45° FOV. 2352x1568: 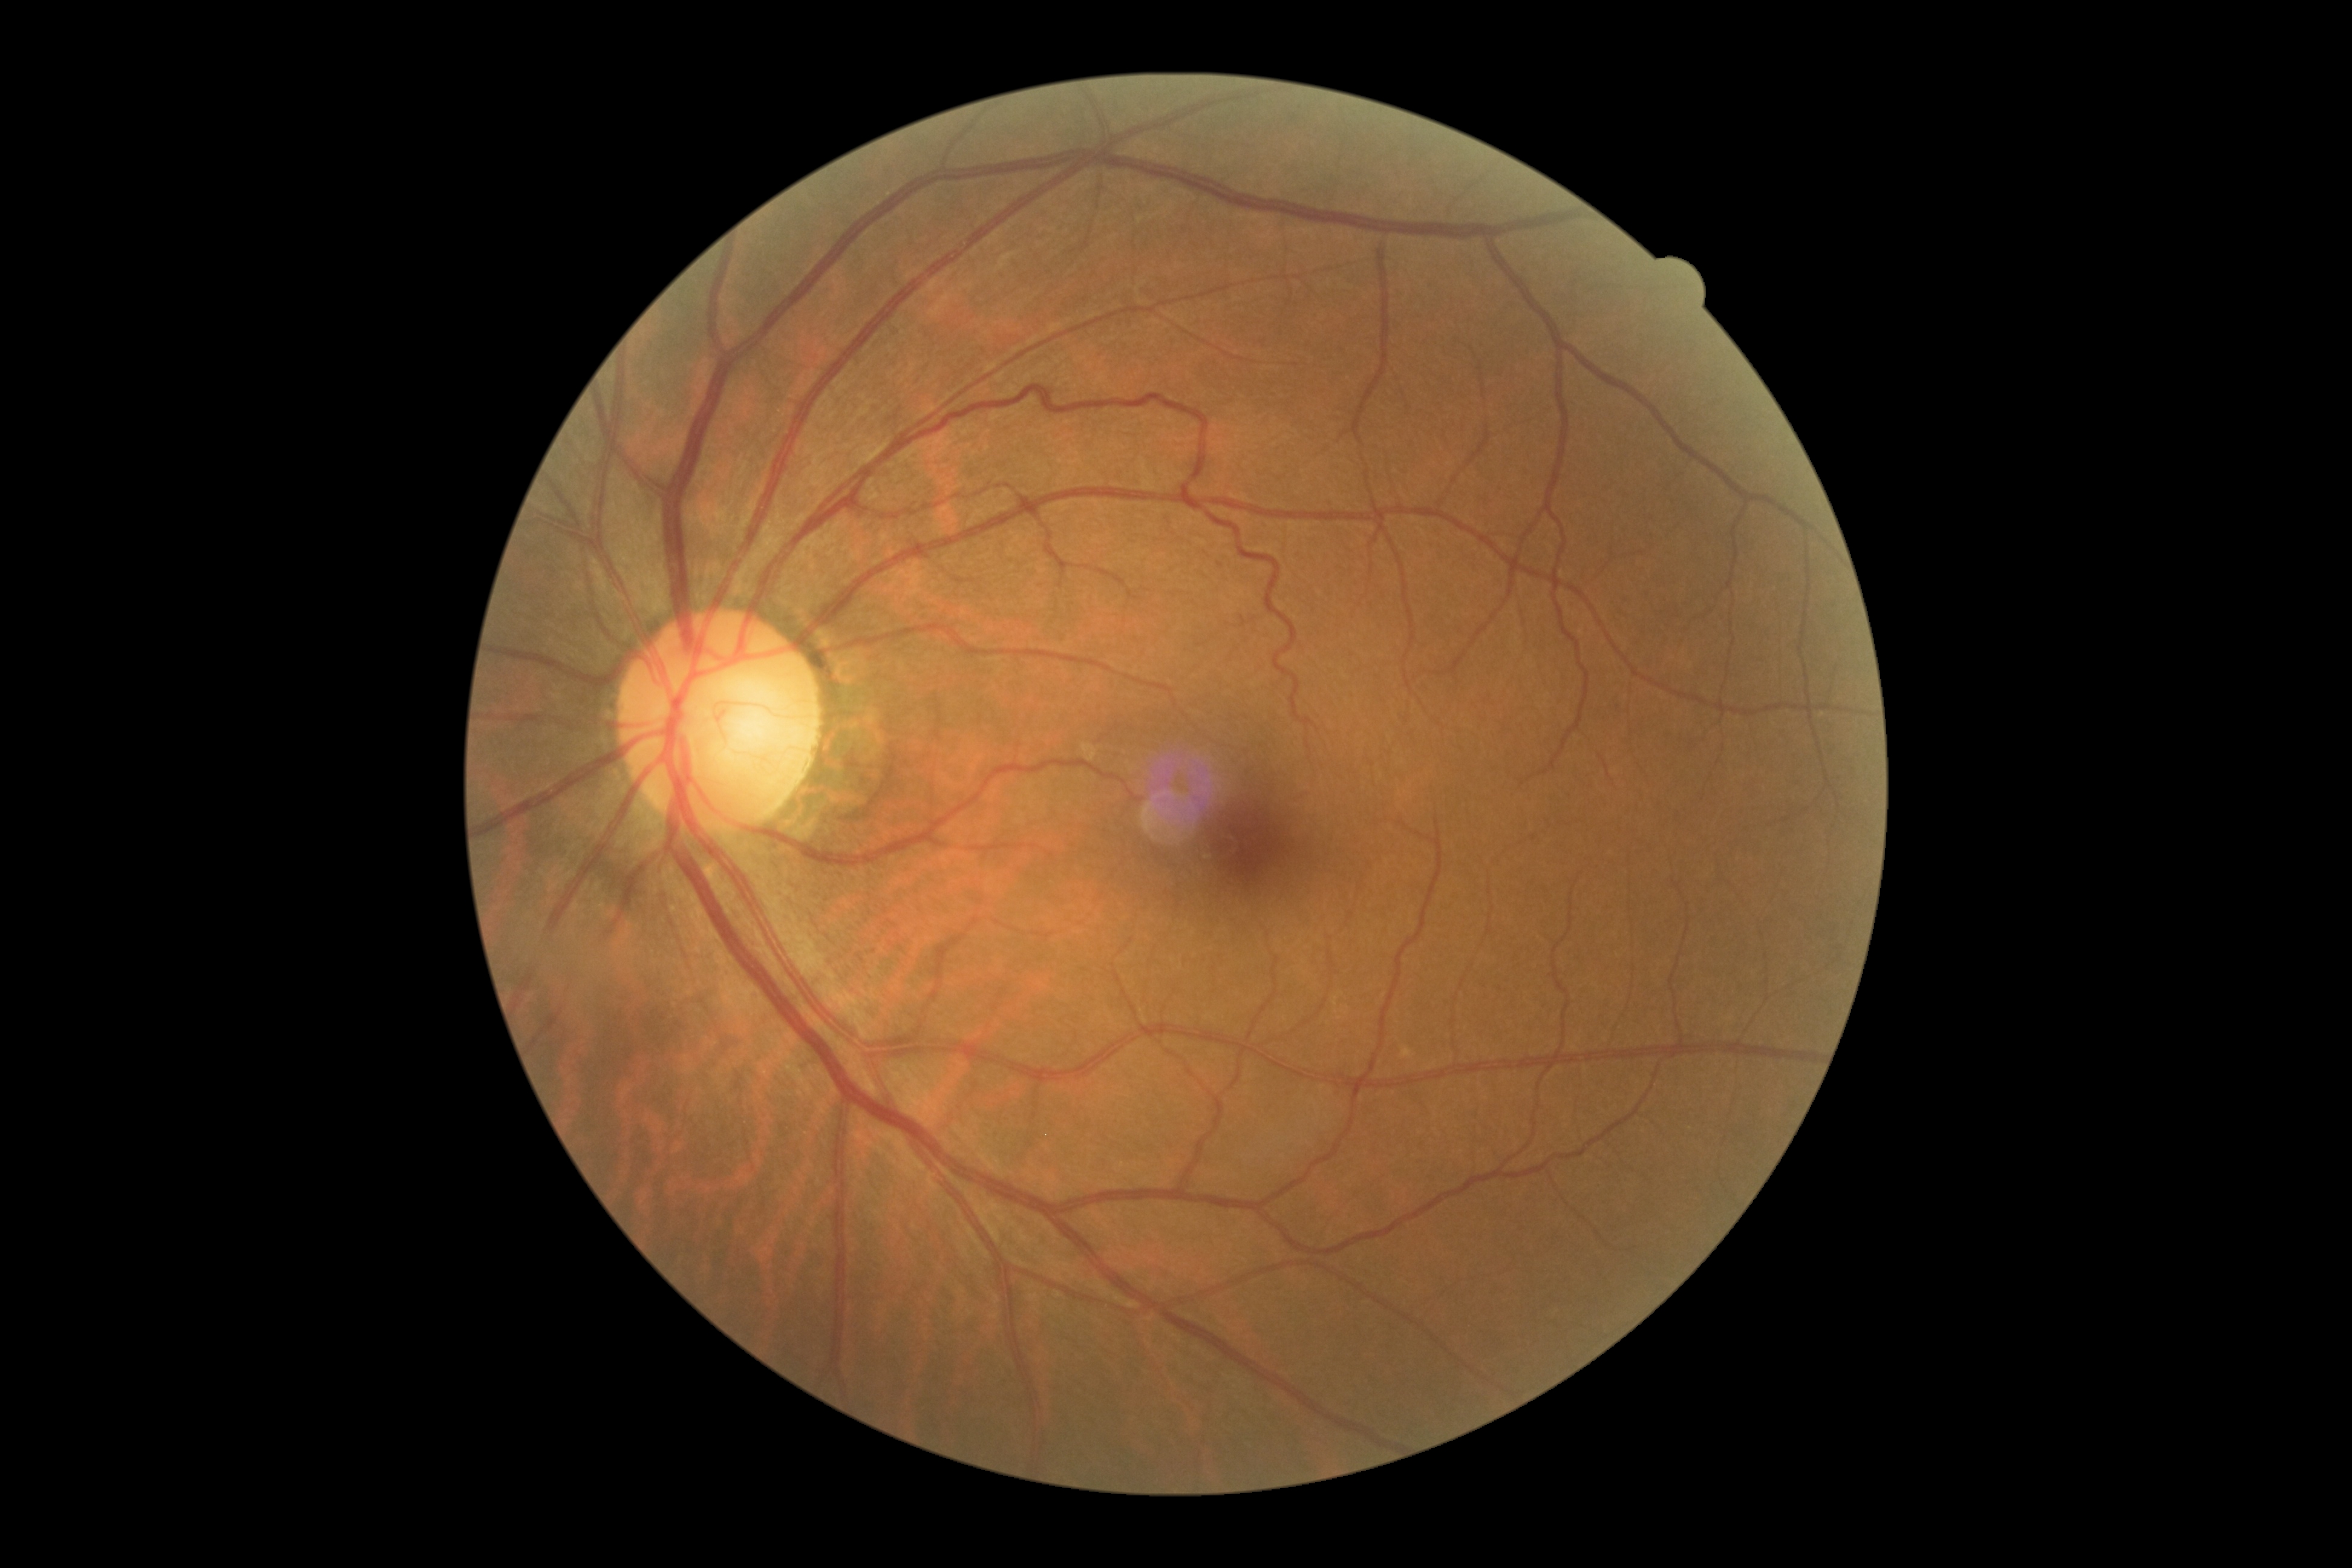 Retinopathy is grade 0 (no apparent retinopathy) — no visible signs of diabetic retinopathy.